Camera: NIDEK AFC-230 · without pupil dilation · 848x848 · posterior pole color fundus photograph · 45° field of view.
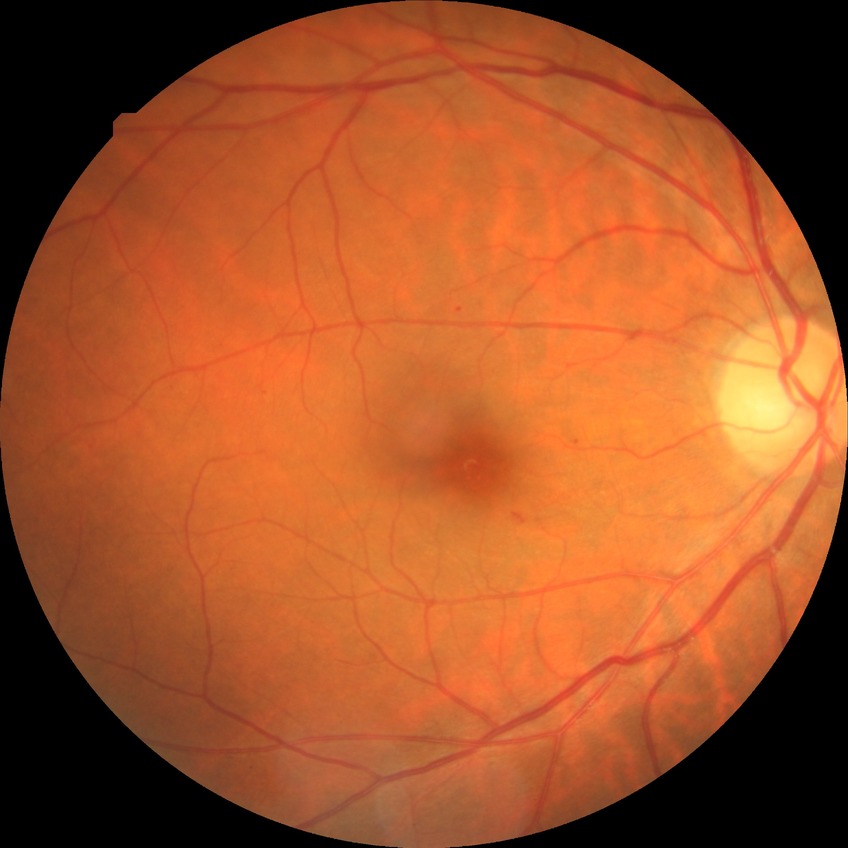
Diabetic retinopathy severity is simple diabetic retinopathy.